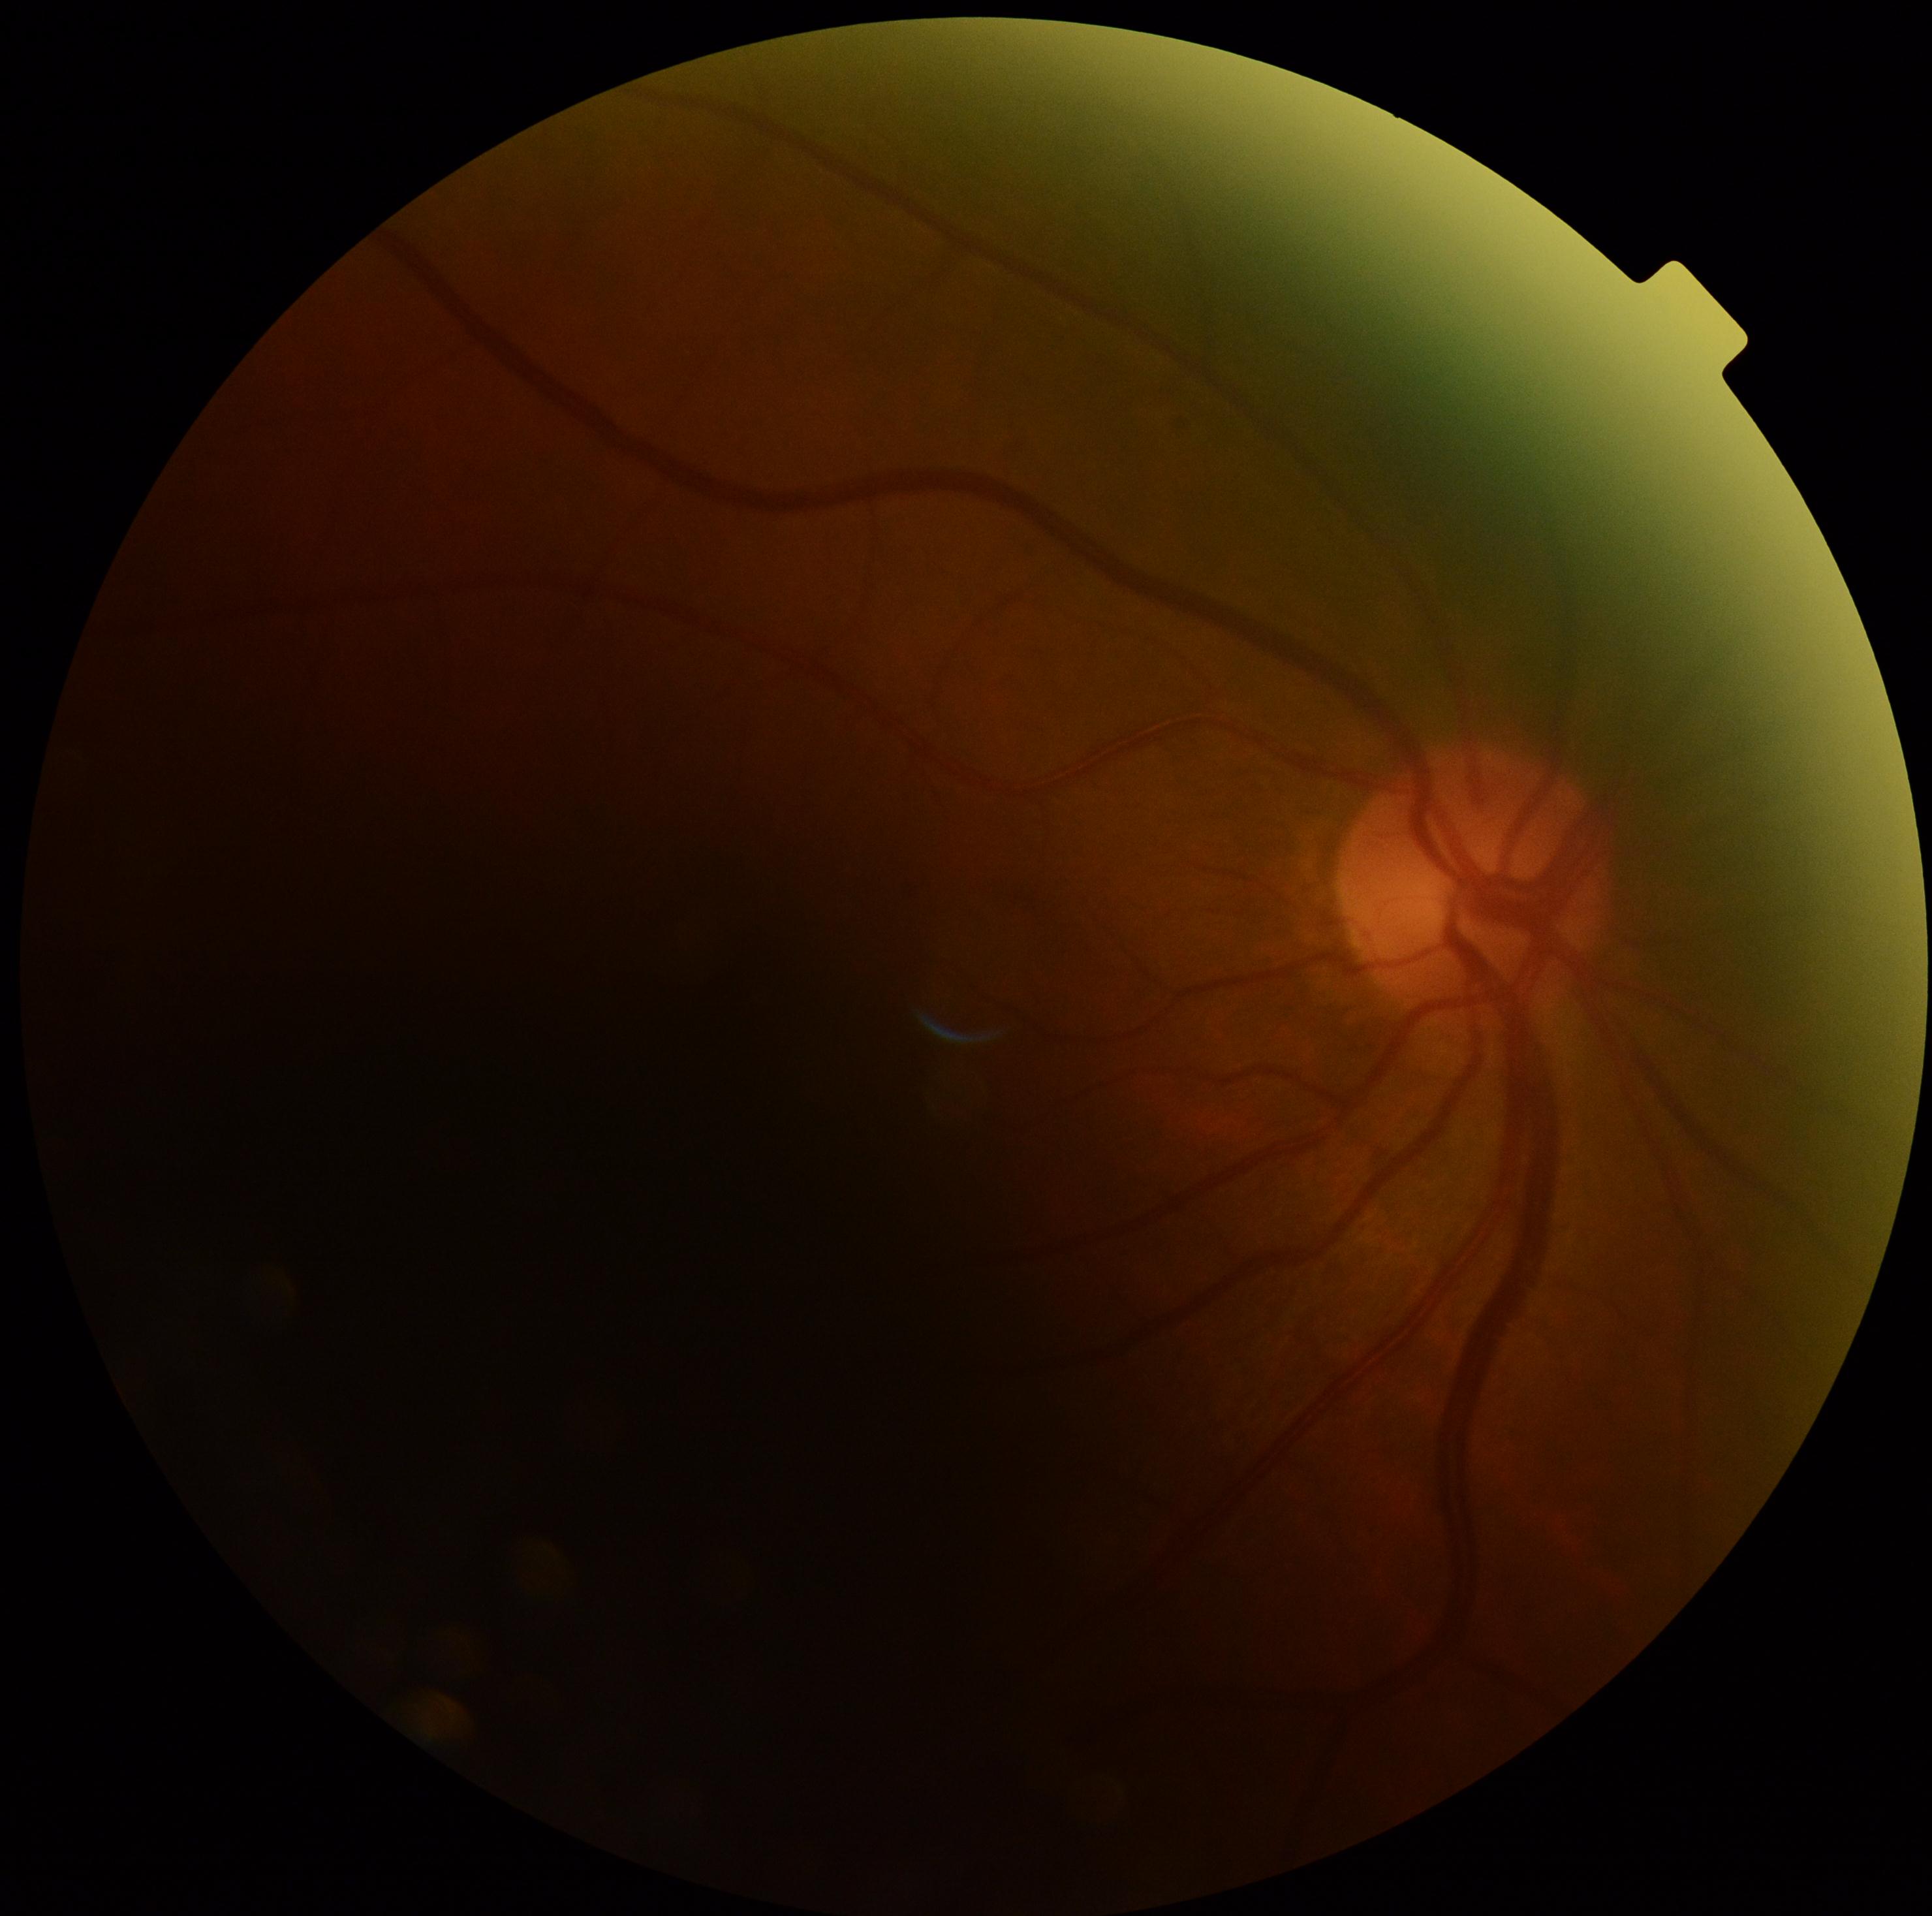
Diabetic retinopathy grade is ungradable.